Graded on the modified Davis scale.
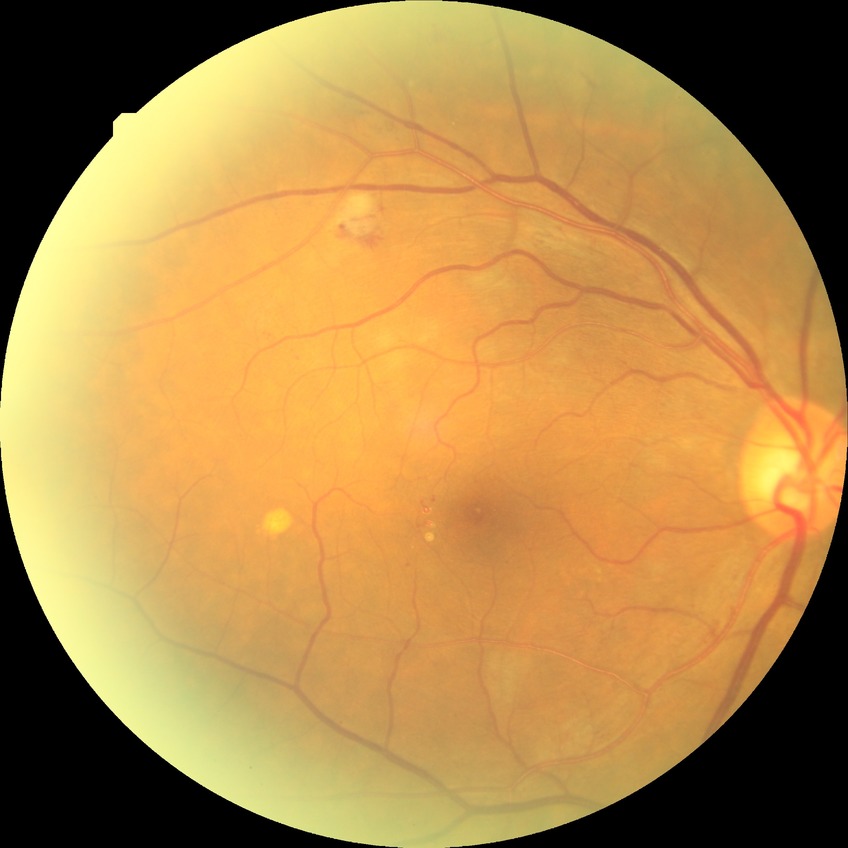 DR class=non-proliferative diabetic retinopathy; modified Davis classification=pre-proliferative diabetic retinopathy.